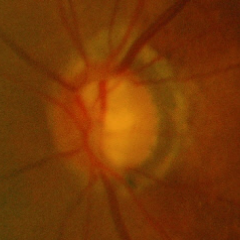

There is evidence of early glaucomatous changes. Diagnostic criteria: glaucomatous retinal nerve fiber layer defects on red-free fundus photography without visual field defects.